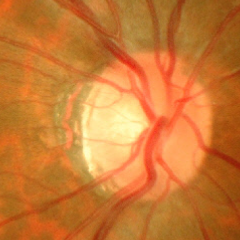
Q: What is the glaucoma diagnosis?
A: Yes — advanced glaucoma.